CFP; FOV: 45 degrees: 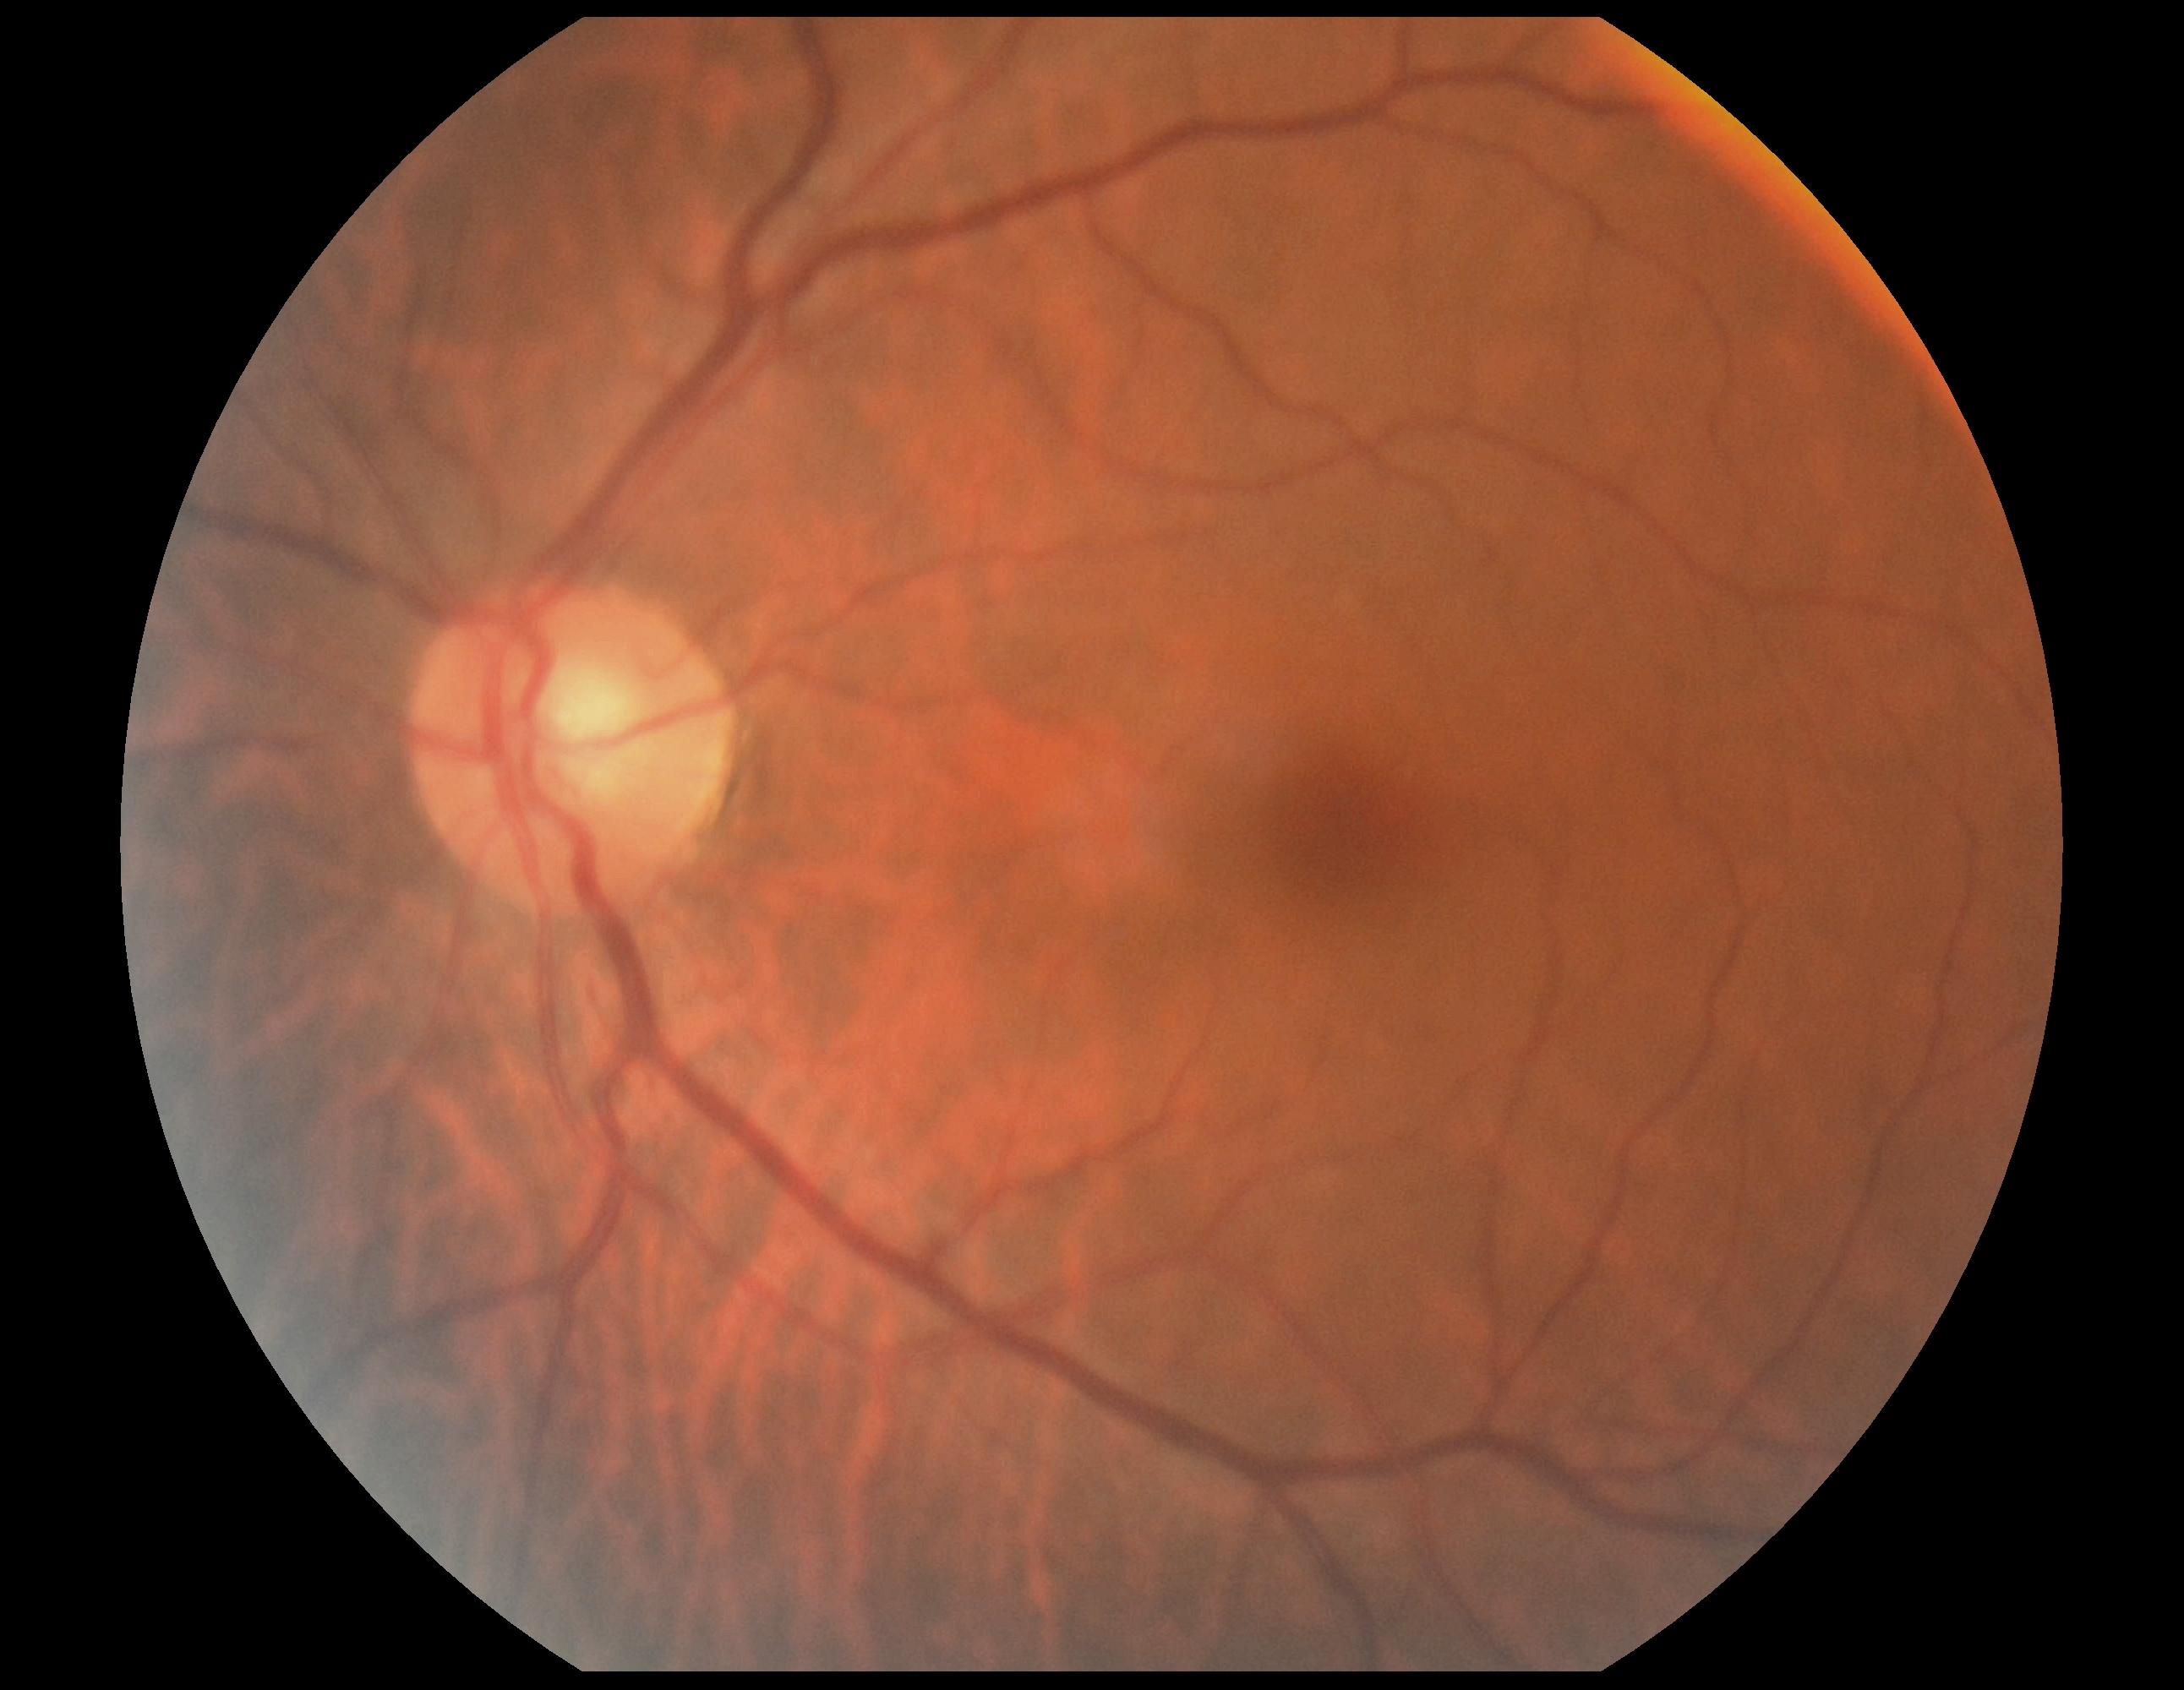
DR stage: grade 0 (no apparent retinopathy).